Female patient. 2212x1661.
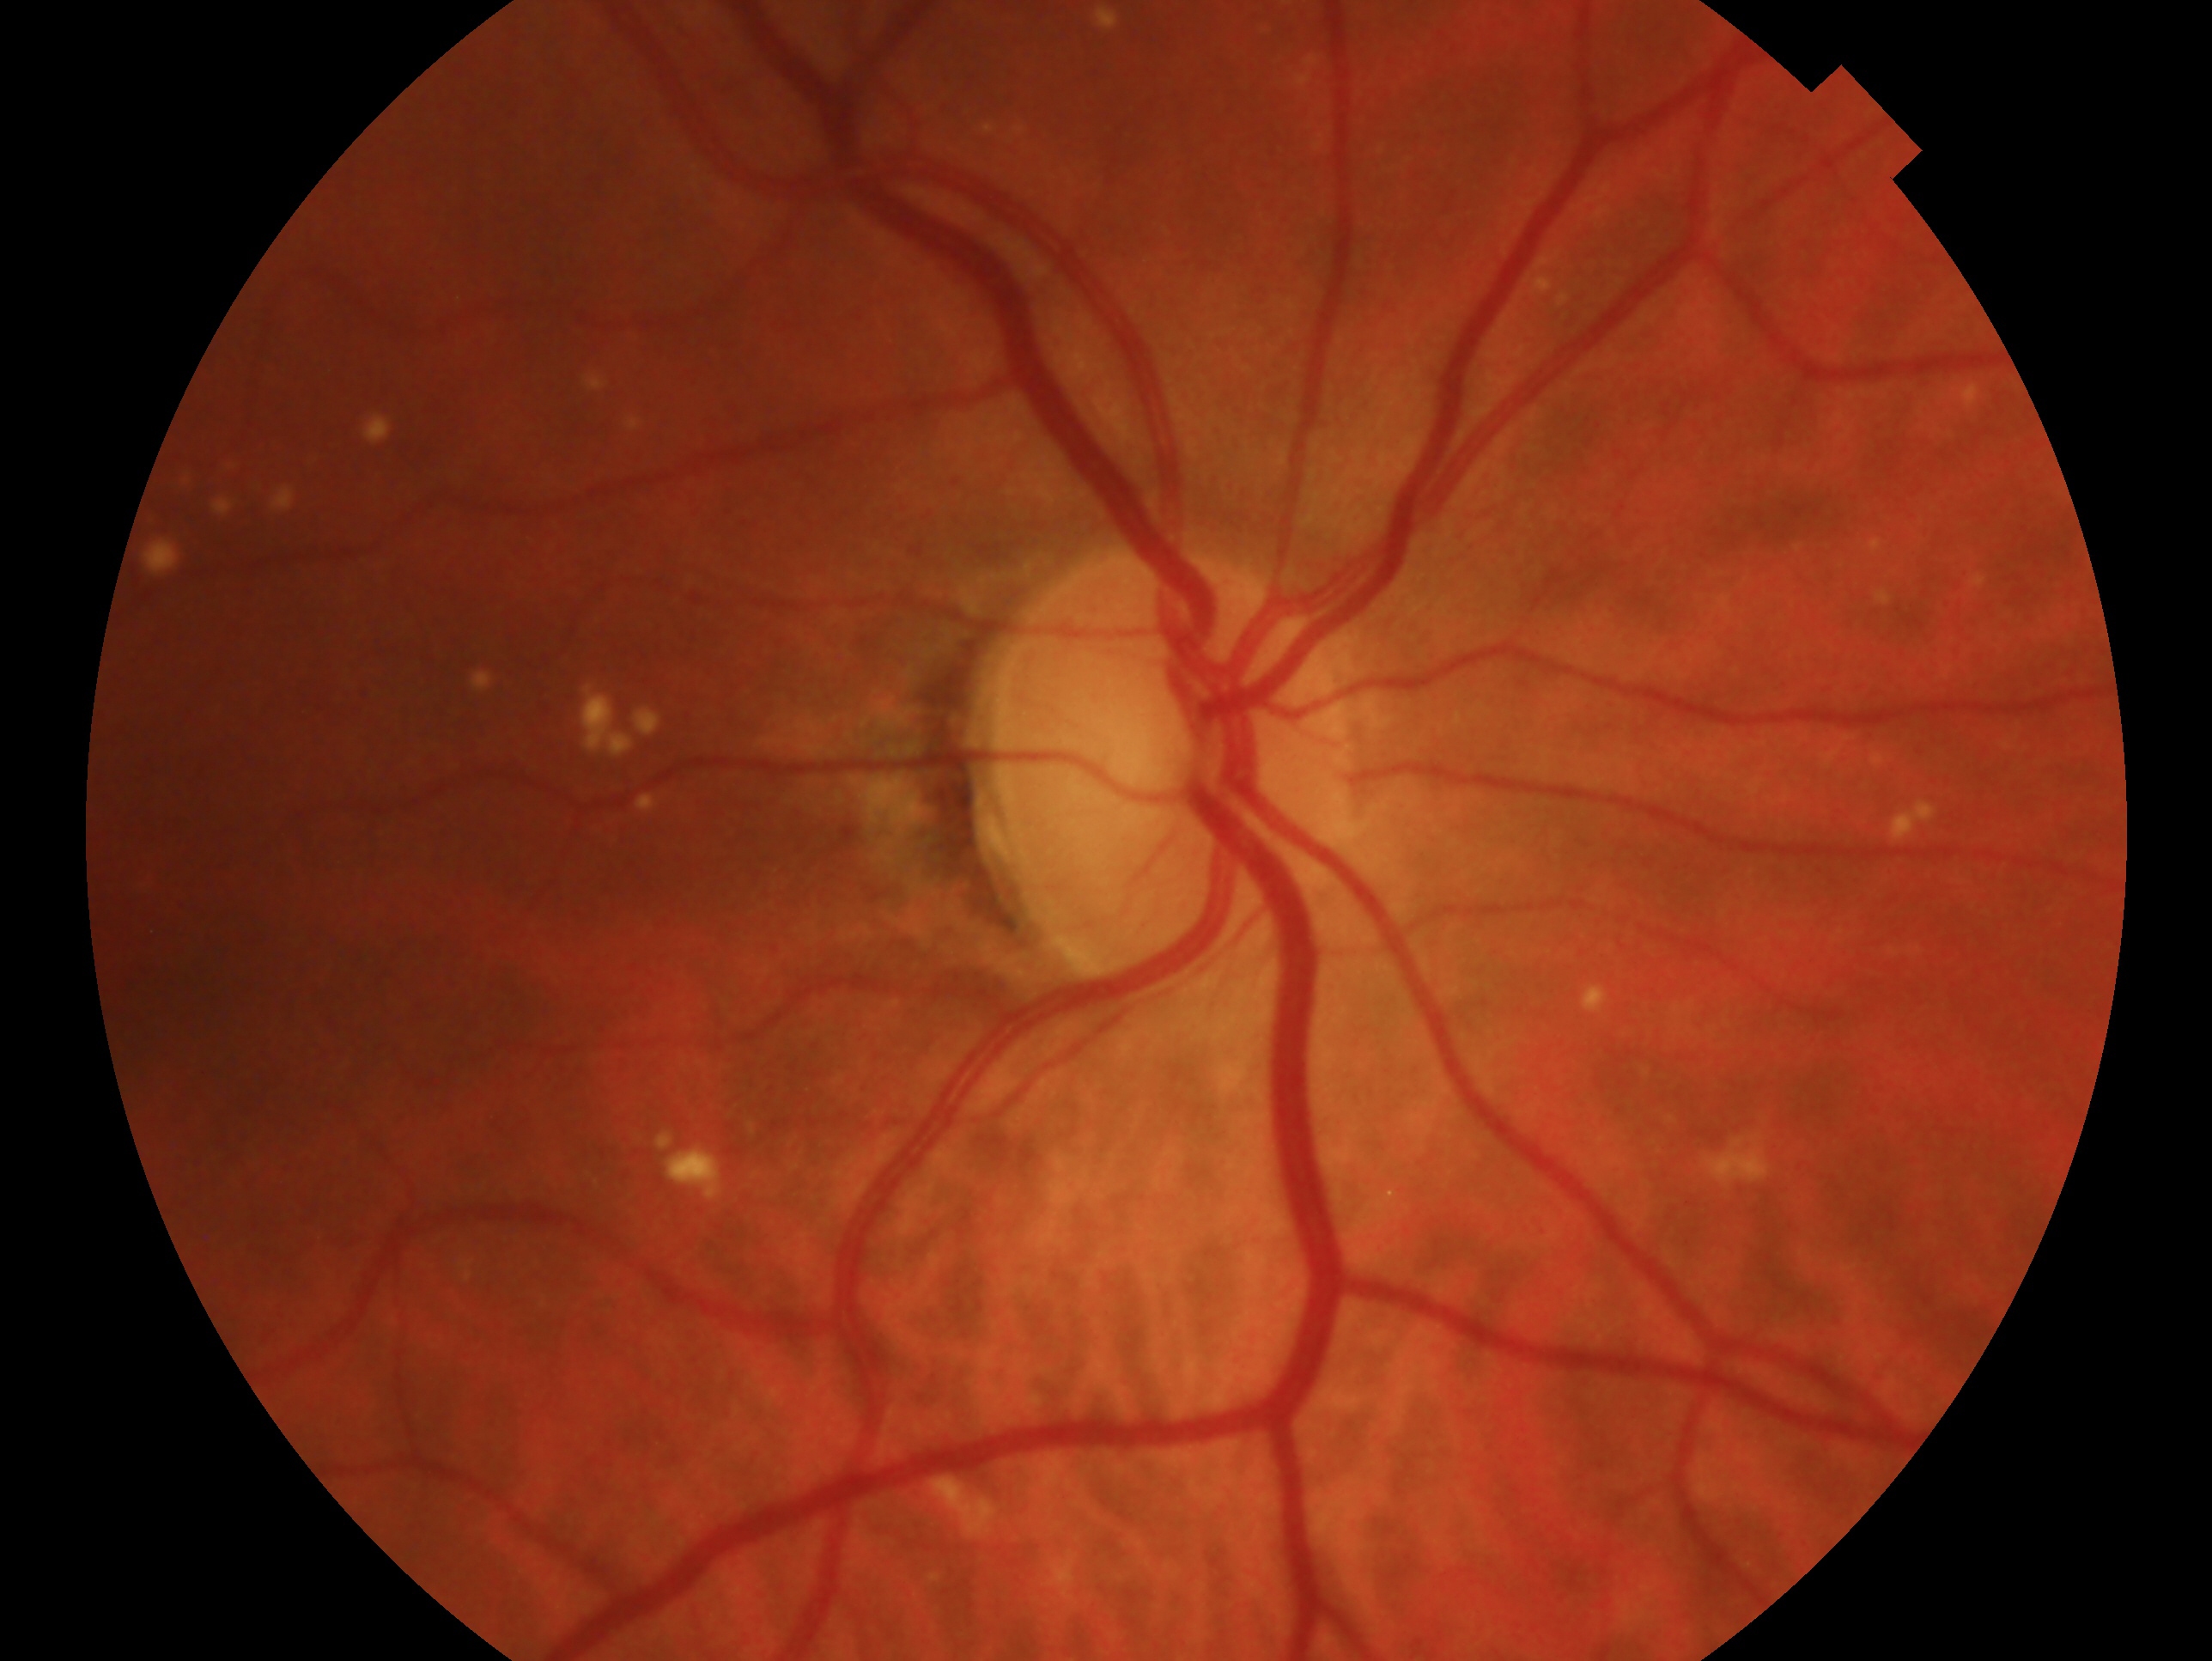
Assessment — no glaucomatous findings. The image shows the oculus dexter.